Camera: Clarity RetCam 3 (130° FOV) · infant wide-field retinal image — 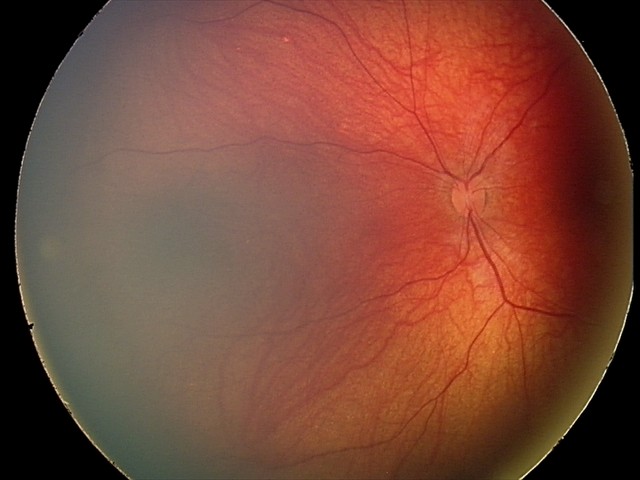

Diagnosis: retinal astrocytic hamartoma